No pharmacologic dilation
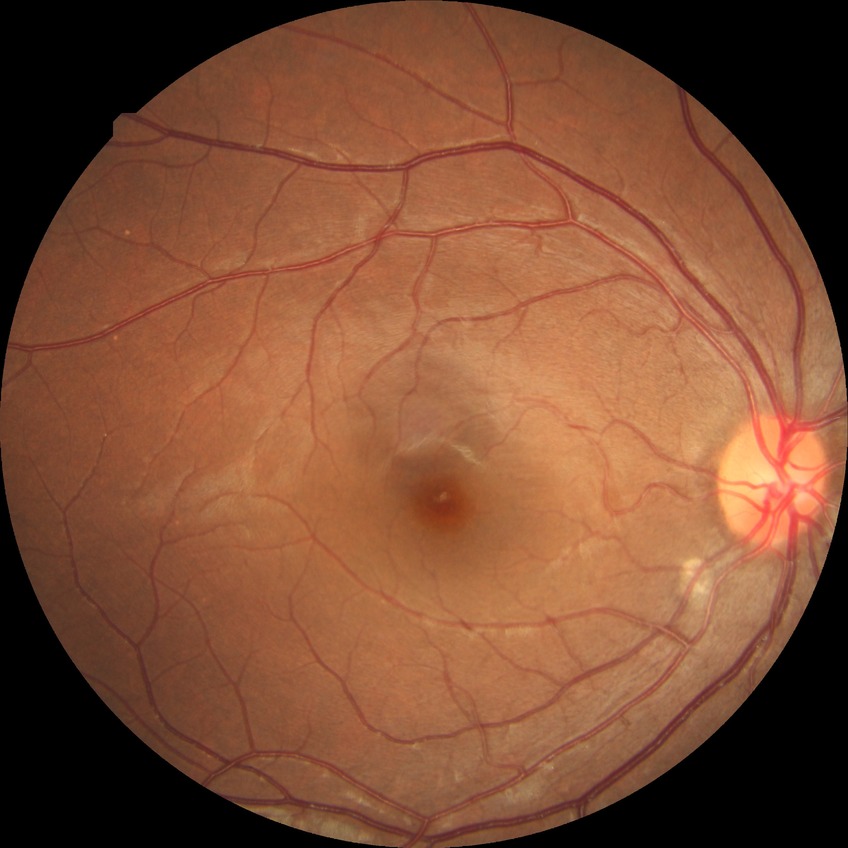 davis_grade: no diabetic retinopathy